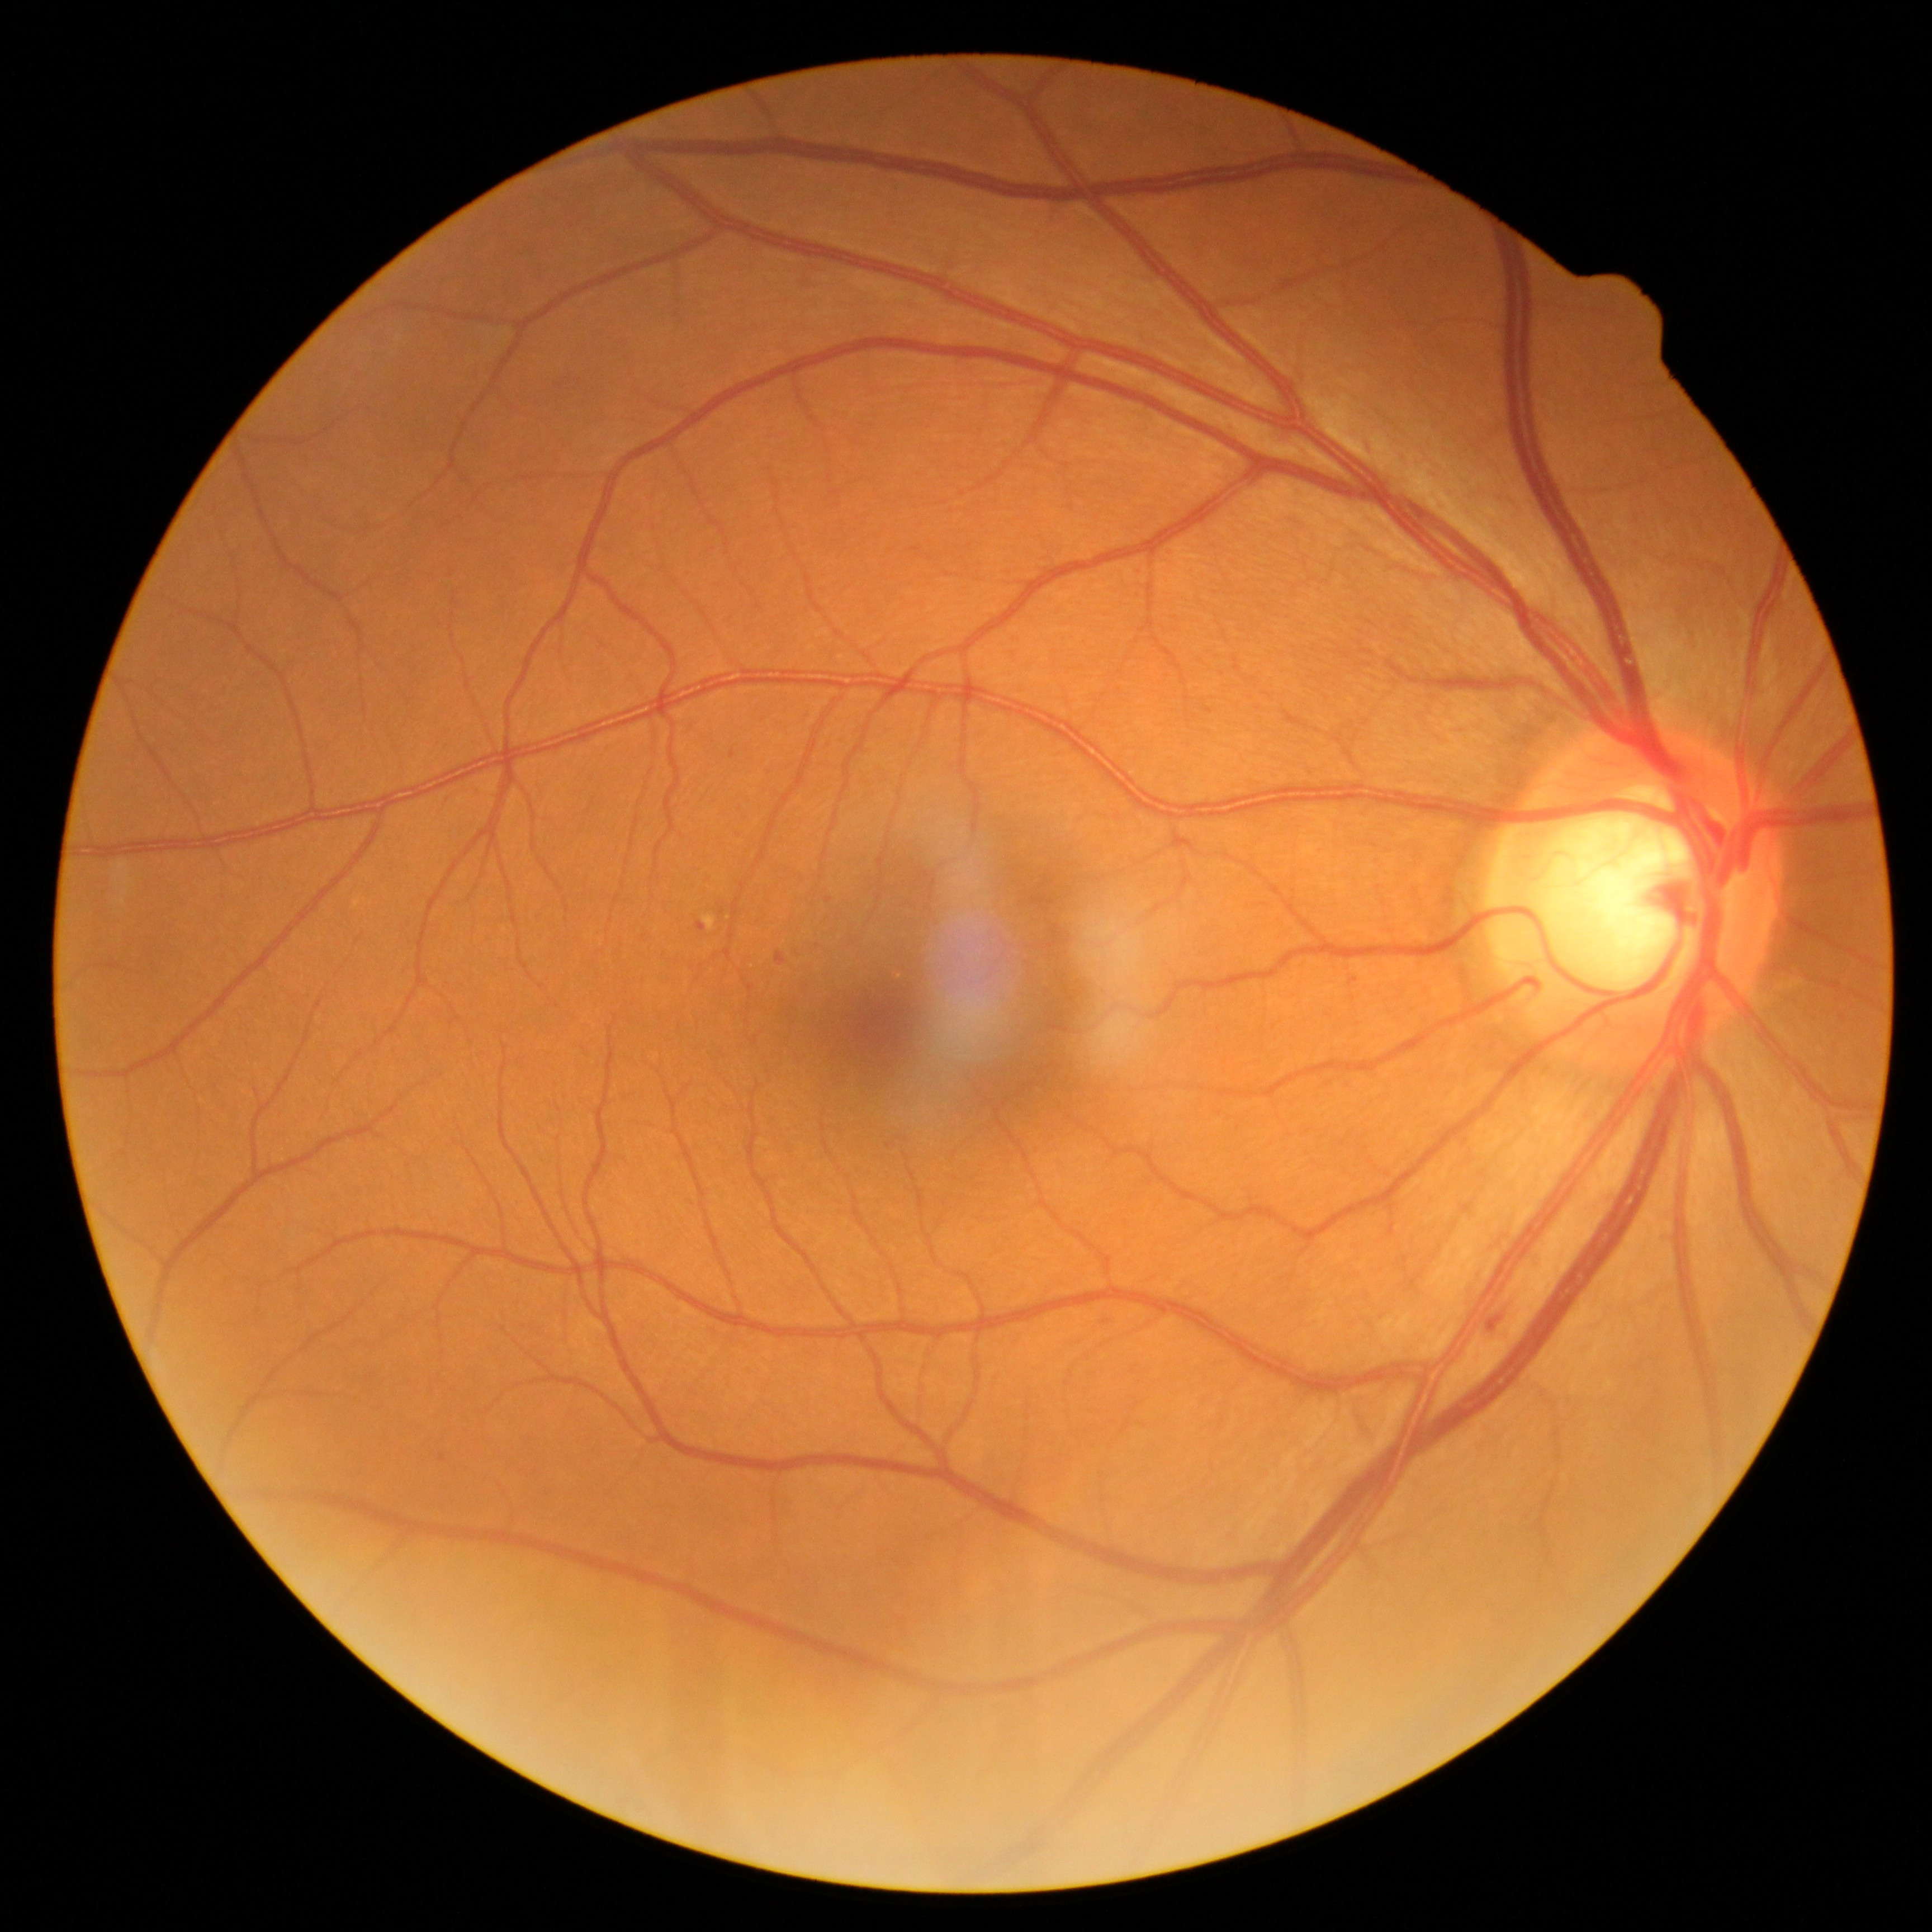

DR stage=grade 2.